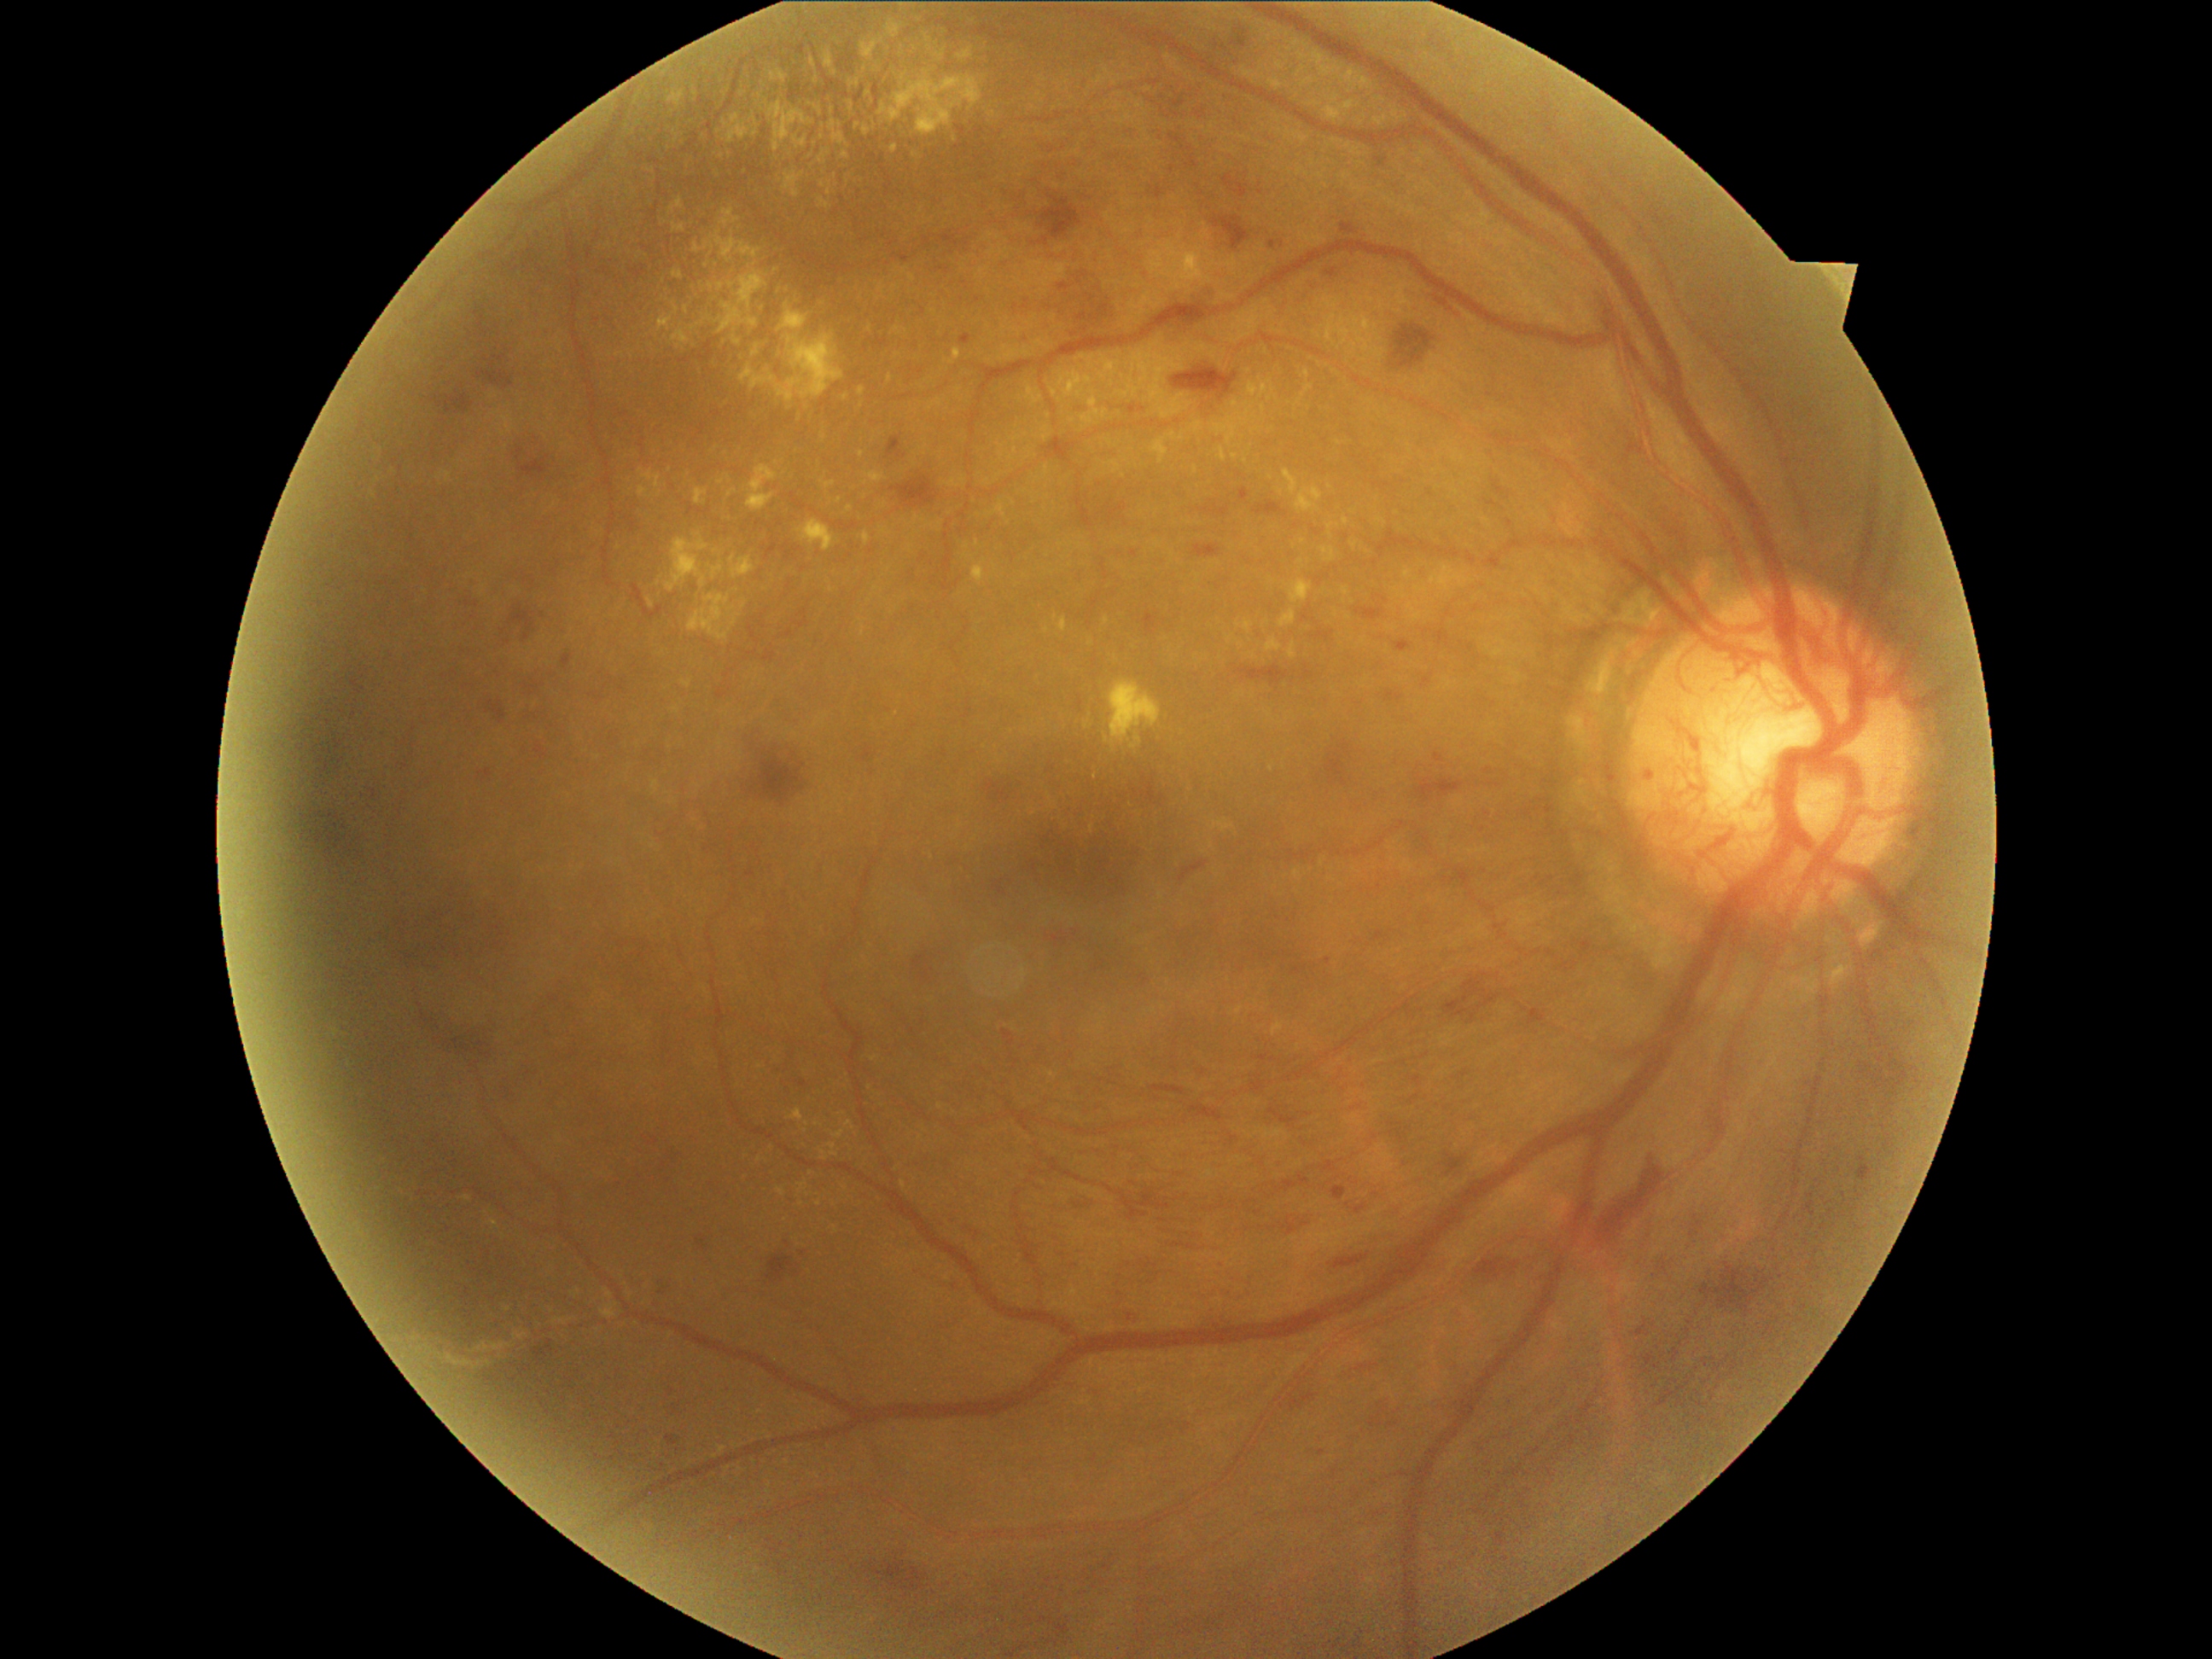 DR stage is PDR (grade 4)
Selected lesions:
EXs (partial): (658, 317, 673, 332) | (721, 209, 738, 228) | (694, 245, 702, 253) | (1103, 617, 1110, 626) | (639, 487, 648, 498) | (1296, 487, 1324, 513) | (765, 102, 815, 153) | (996, 501, 1006, 518) | (672, 224, 687, 233) | (772, 286, 800, 301) | (1071, 380, 1074, 392) | (1310, 102, 1322, 107) | (832, 132, 847, 146) | (605, 1289, 615, 1300)
Smaller EXs around (840, 125) | (817, 1125) | (864, 630) | (807, 1124) | (431, 1349) | (1345, 523)